RetCam wide-field infant fundus image — 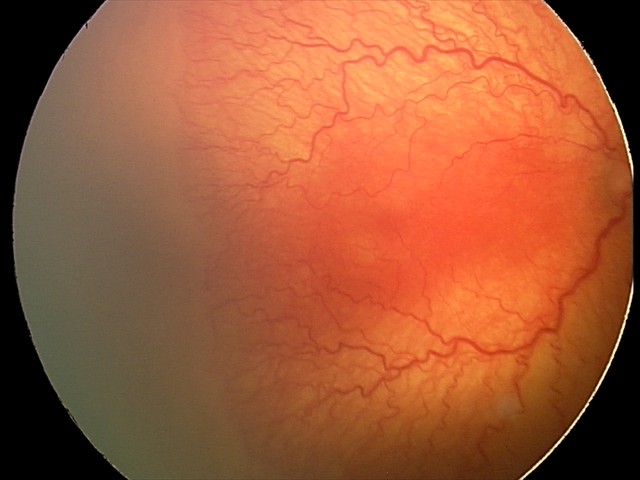 With plus disease.
Series diagnosed as aggressive retinopathy of prematurity (A-ROP).